Nonmydriatic fundus photograph · acquired with a NIDEK AFC-230: 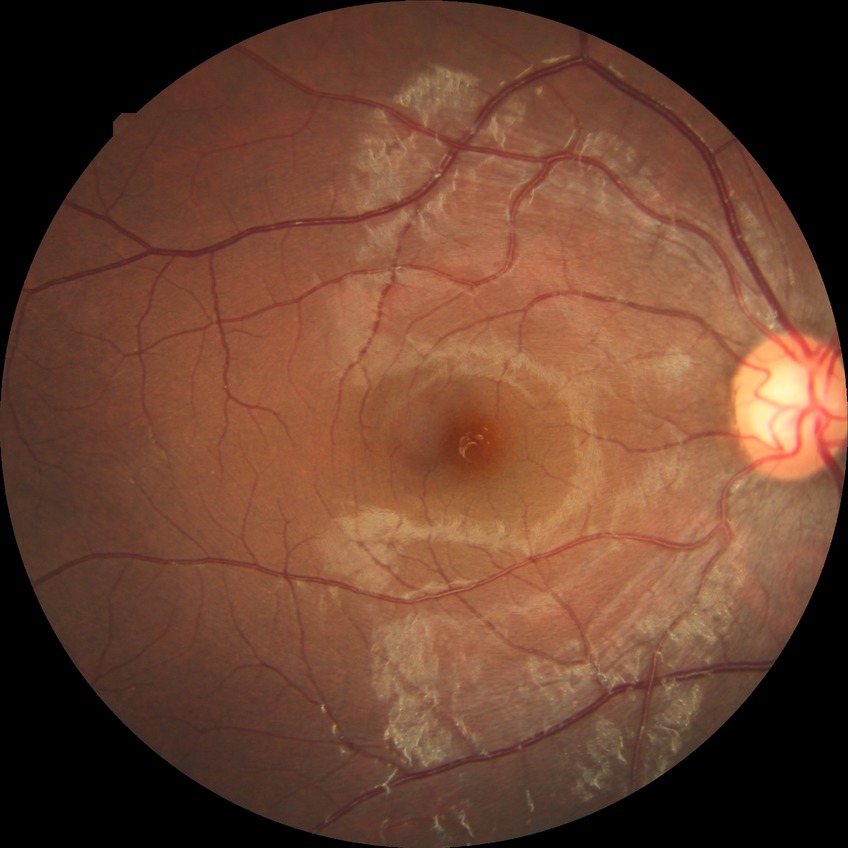 Annotations:
* diabetic retinopathy grade: no diabetic retinopathy